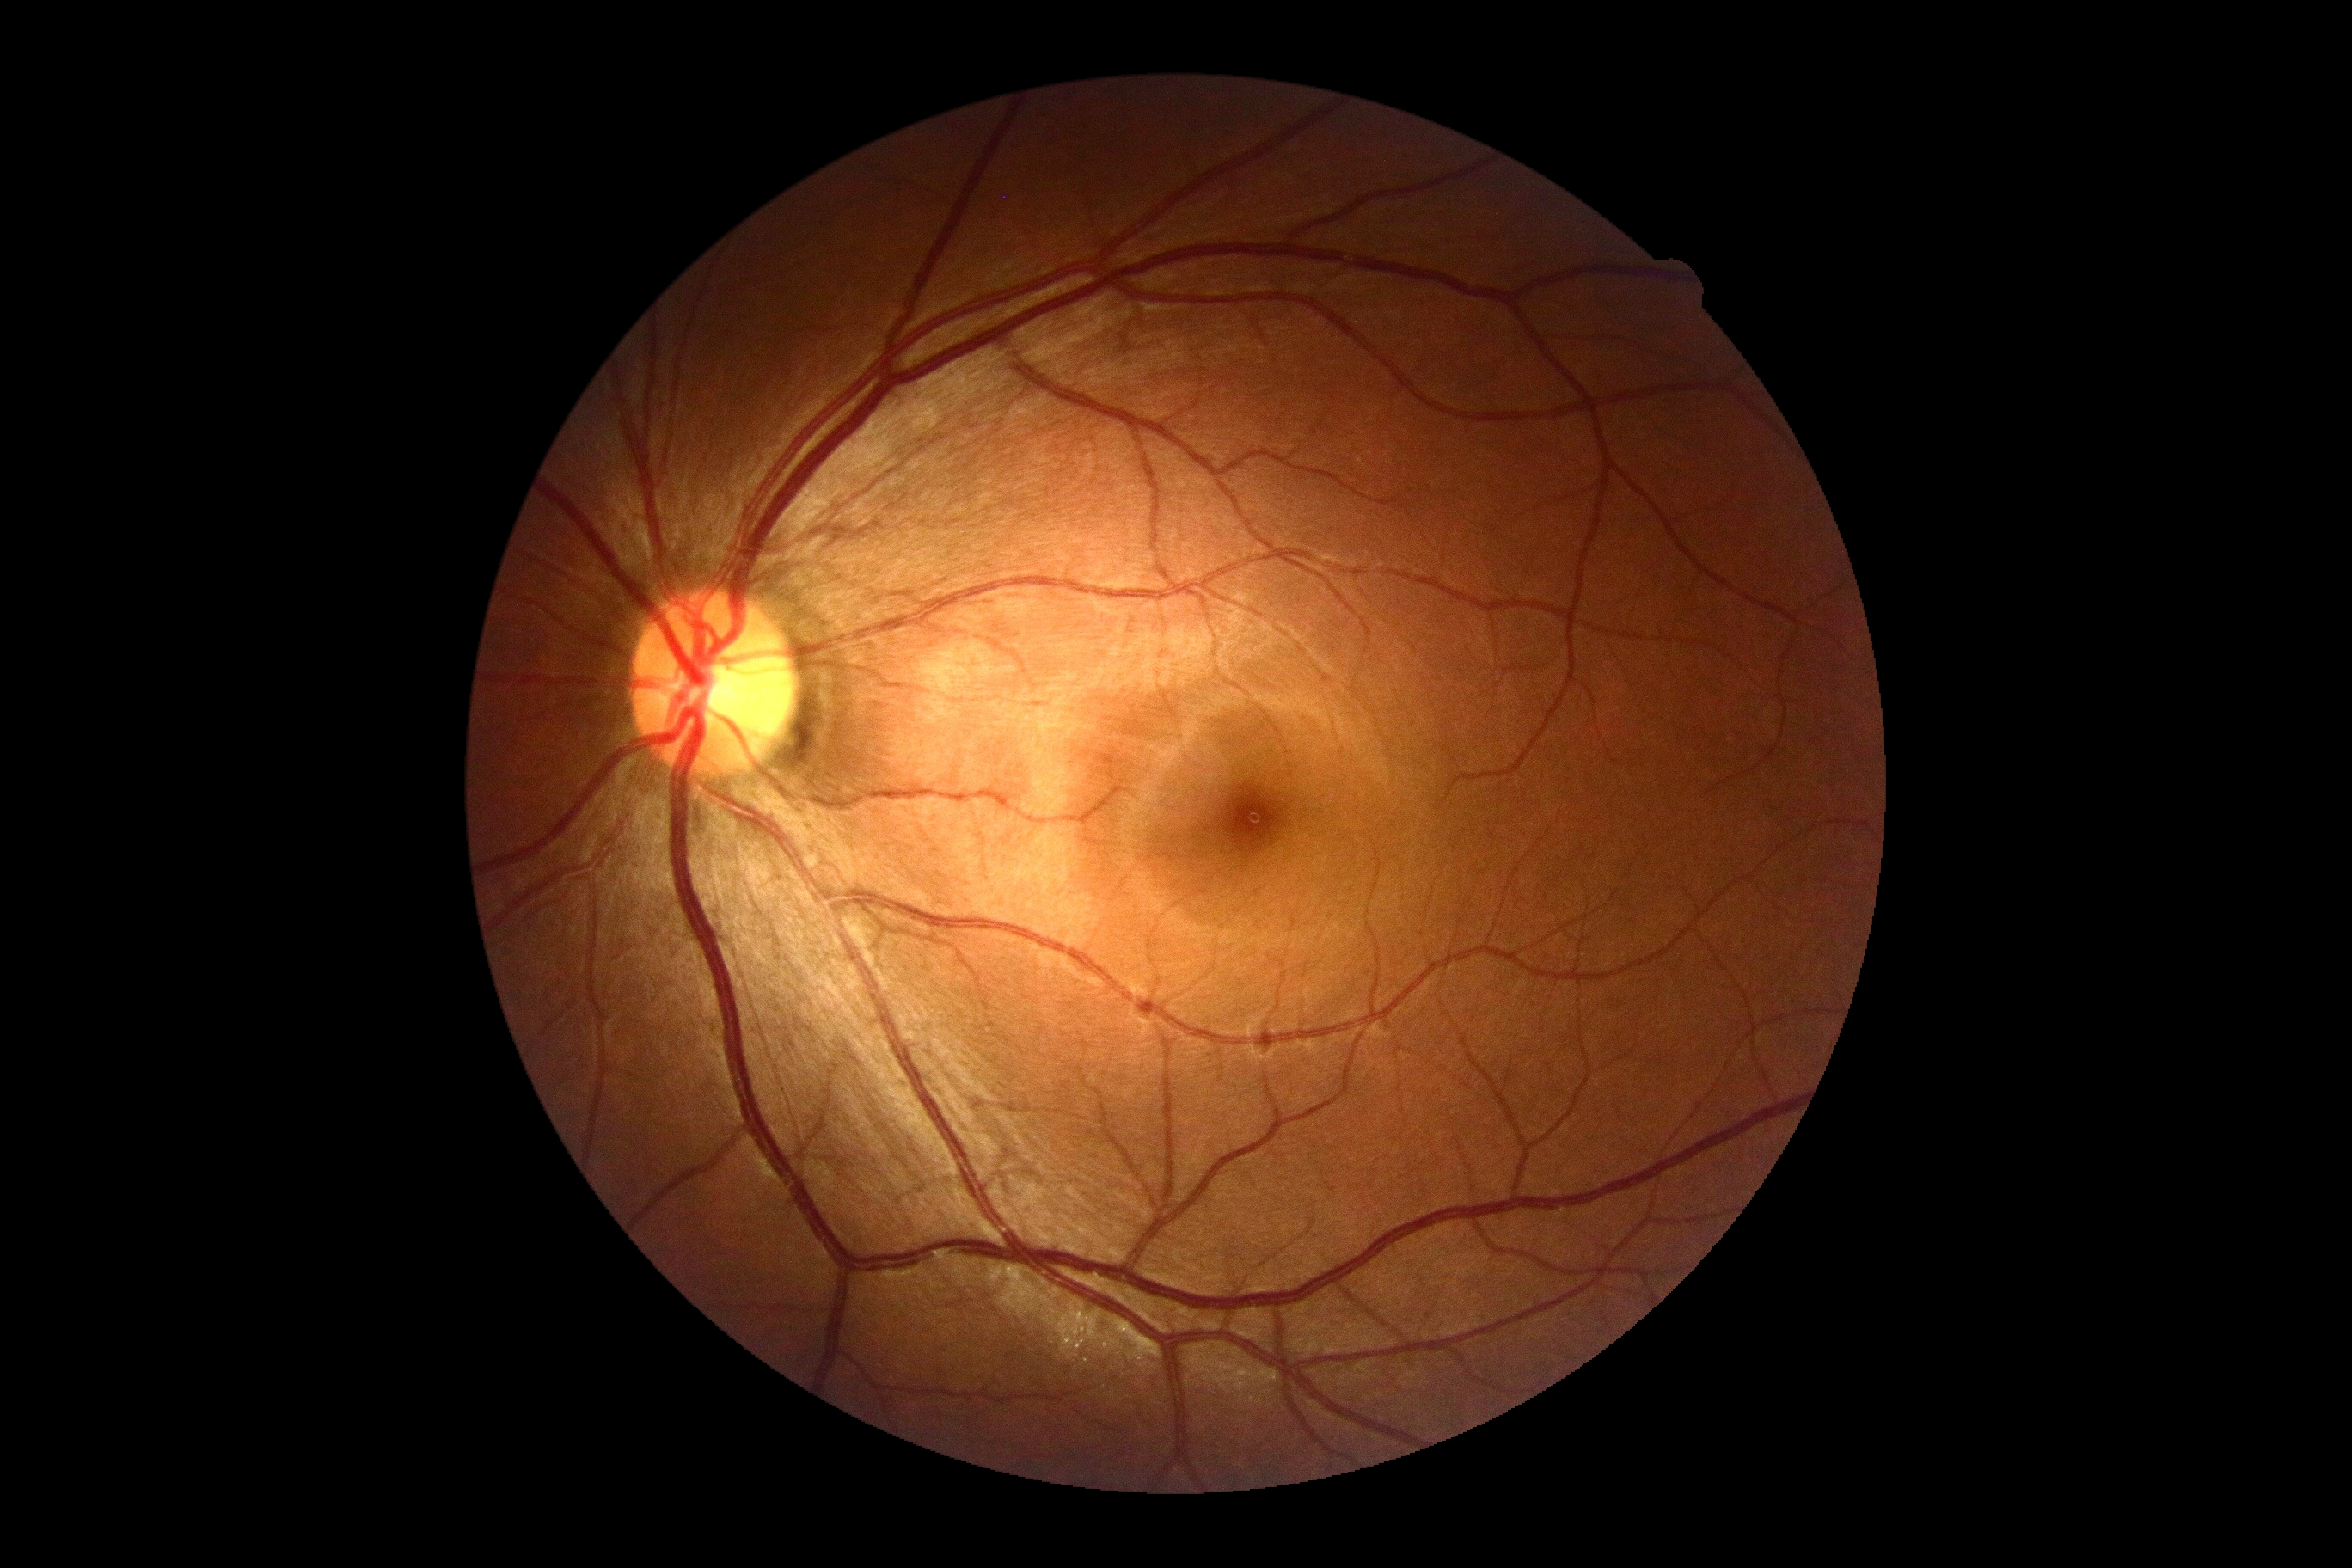
Findings:
– DR impression — no apparent DR
– diabetic retinopathy severity — grade 0 (no apparent retinopathy) — no visible signs of diabetic retinopathy